CFP; 2352x1568px — 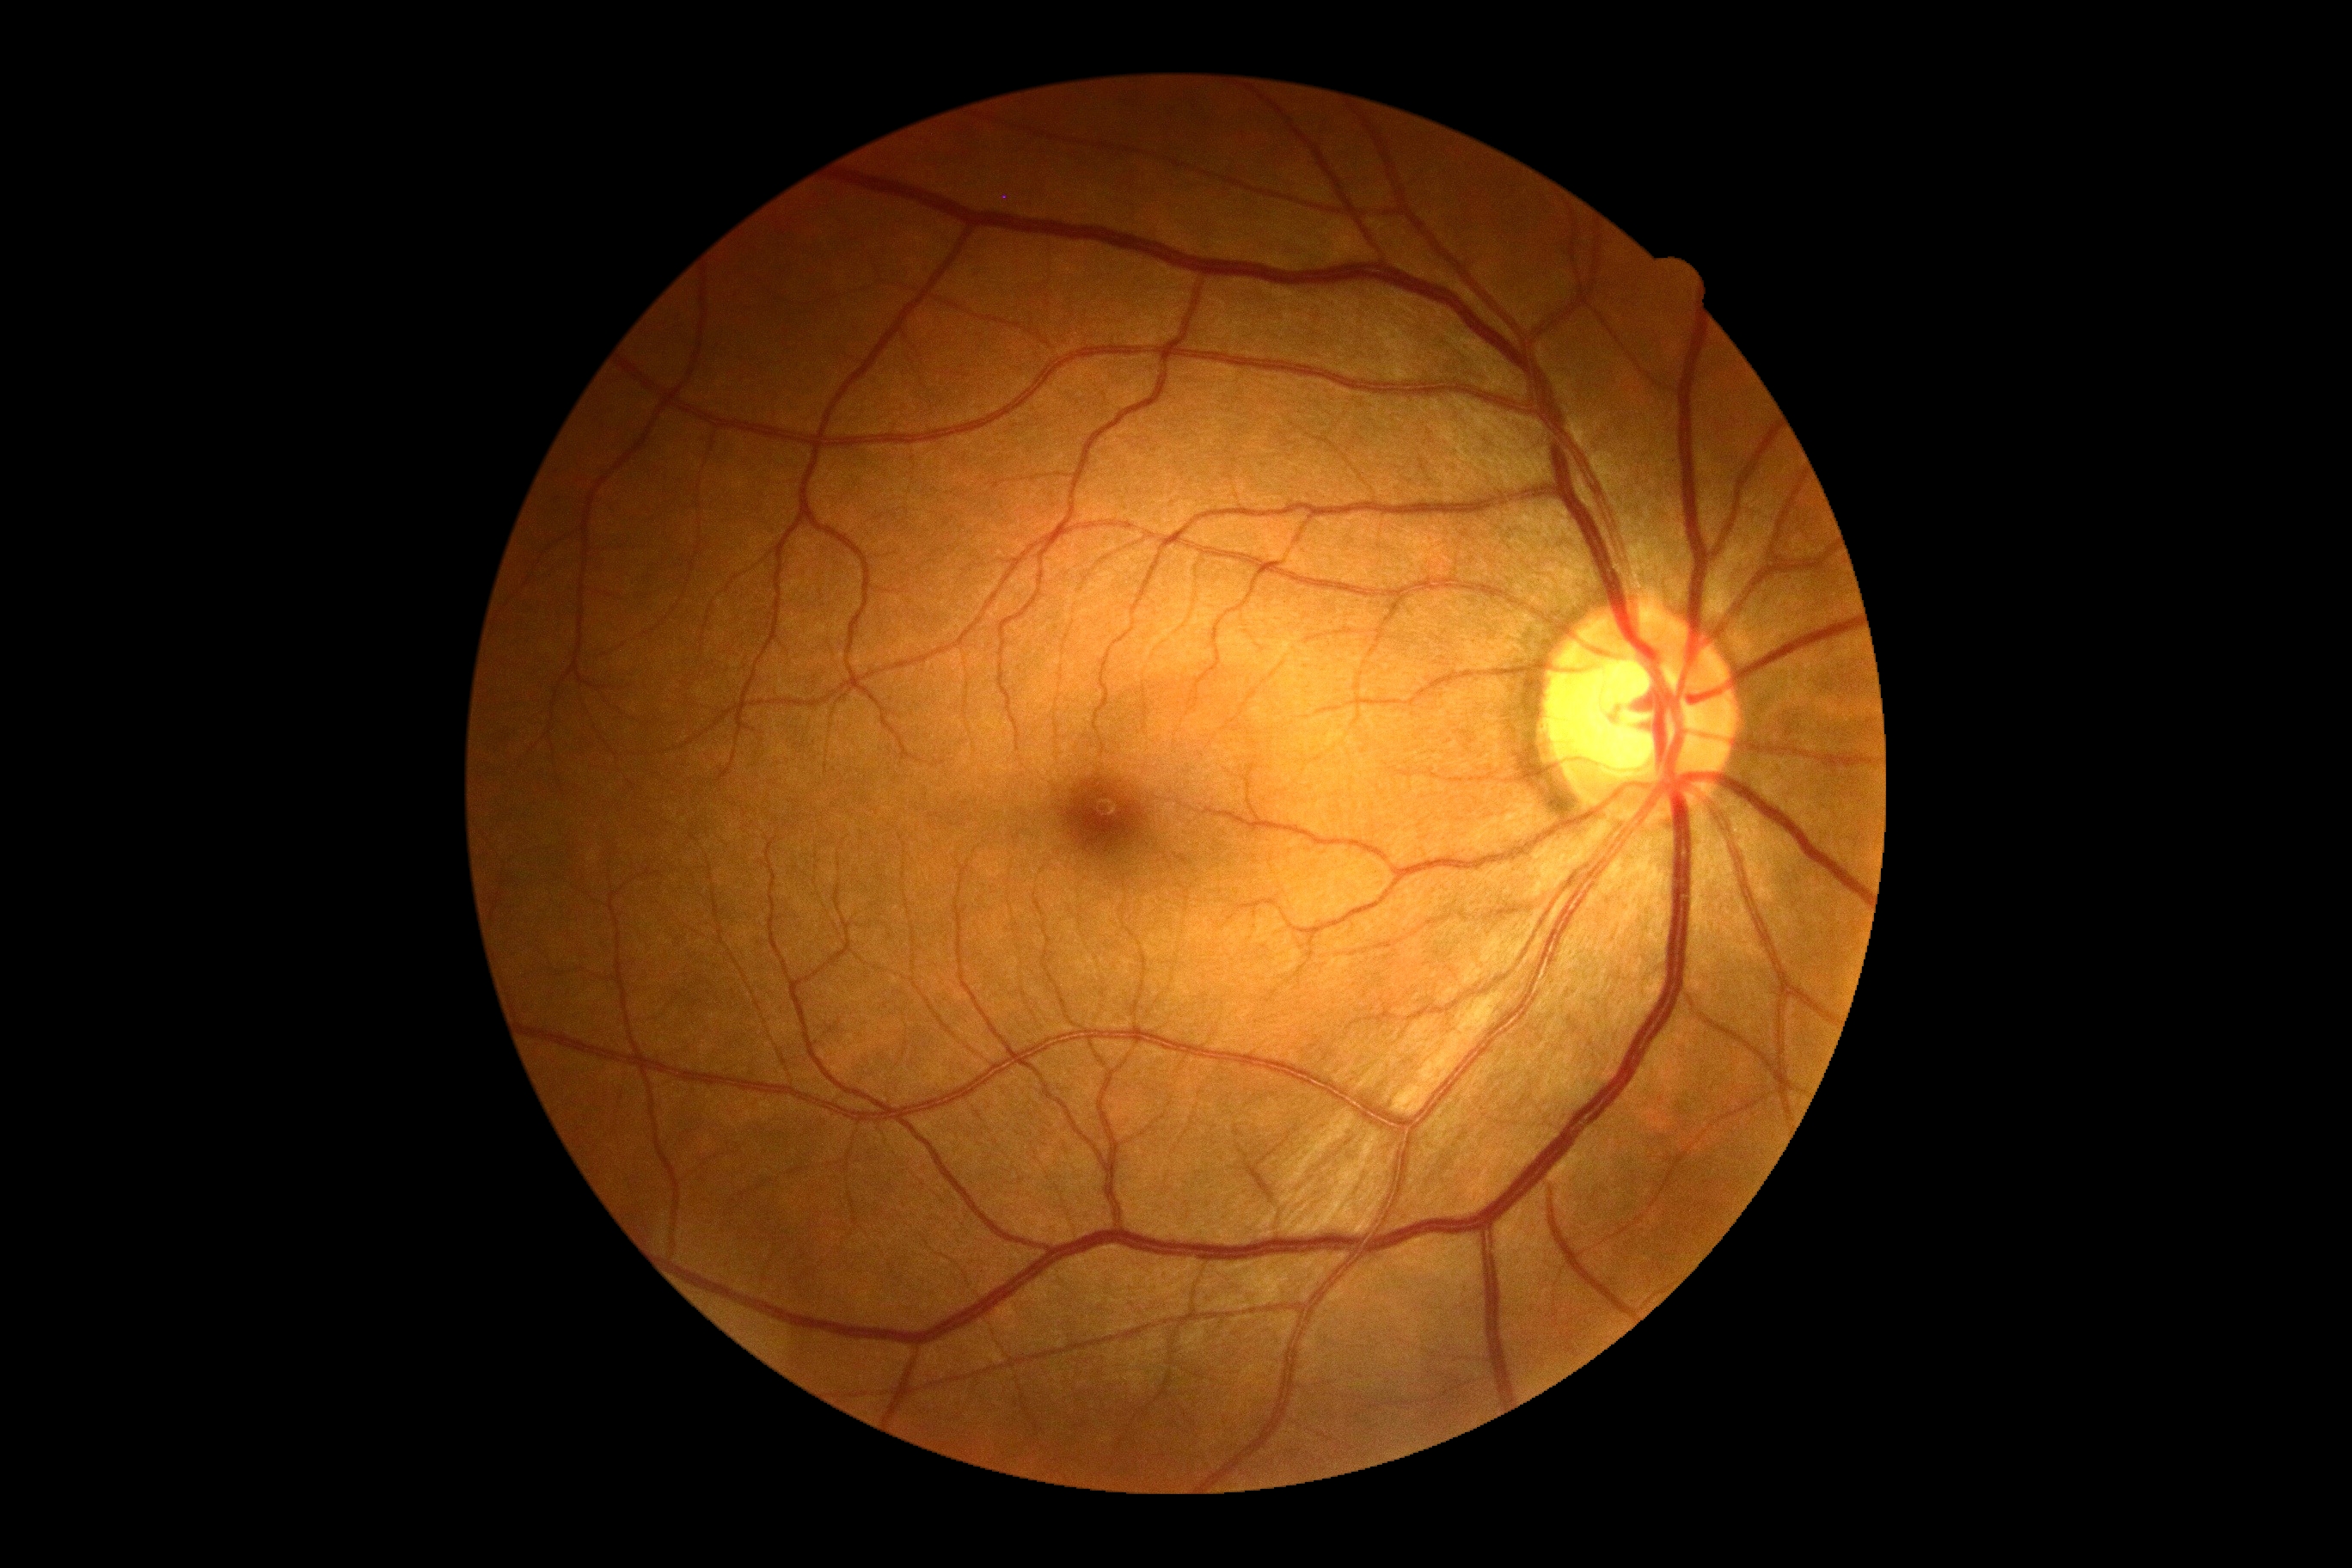

DR grade: 0 (no apparent retinopathy).